45-degree field of view
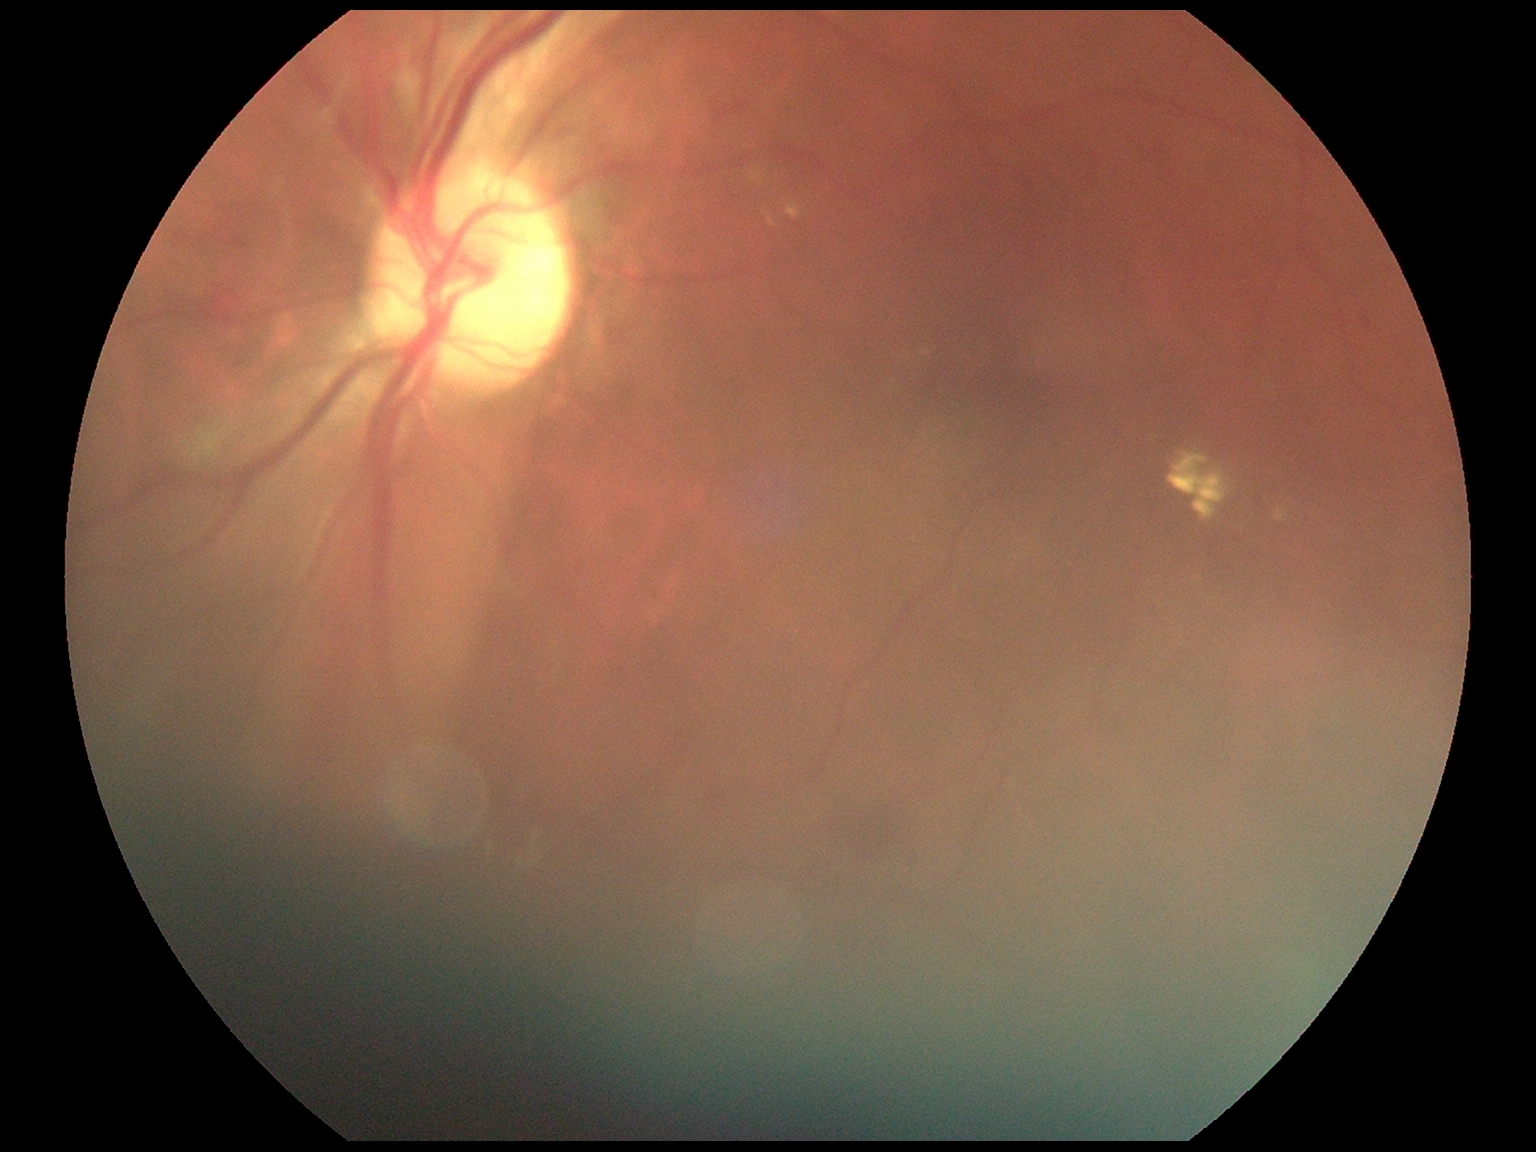 Diabetic retinopathy (DR): grade 2 (moderate NPDR). Disease class: non-proliferative diabetic retinopathy.